640 by 480 pixels. Acquired on the Clarity RetCam 3. Wide-field fundus image from infant ROP screening:
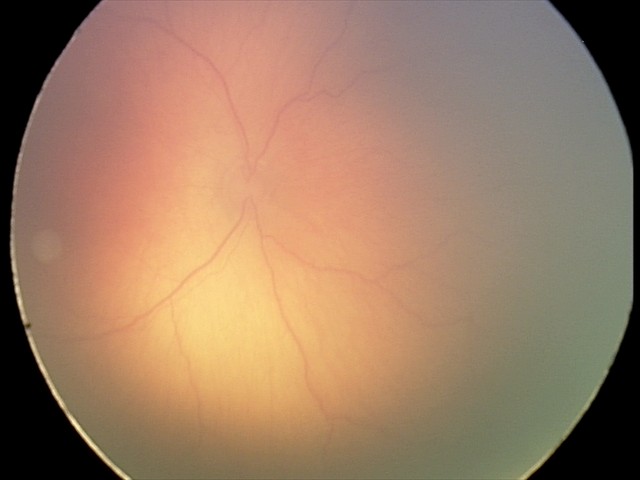

Screening examination consistent with ROP stage 1.